Color fundus photograph · 45° FOV: 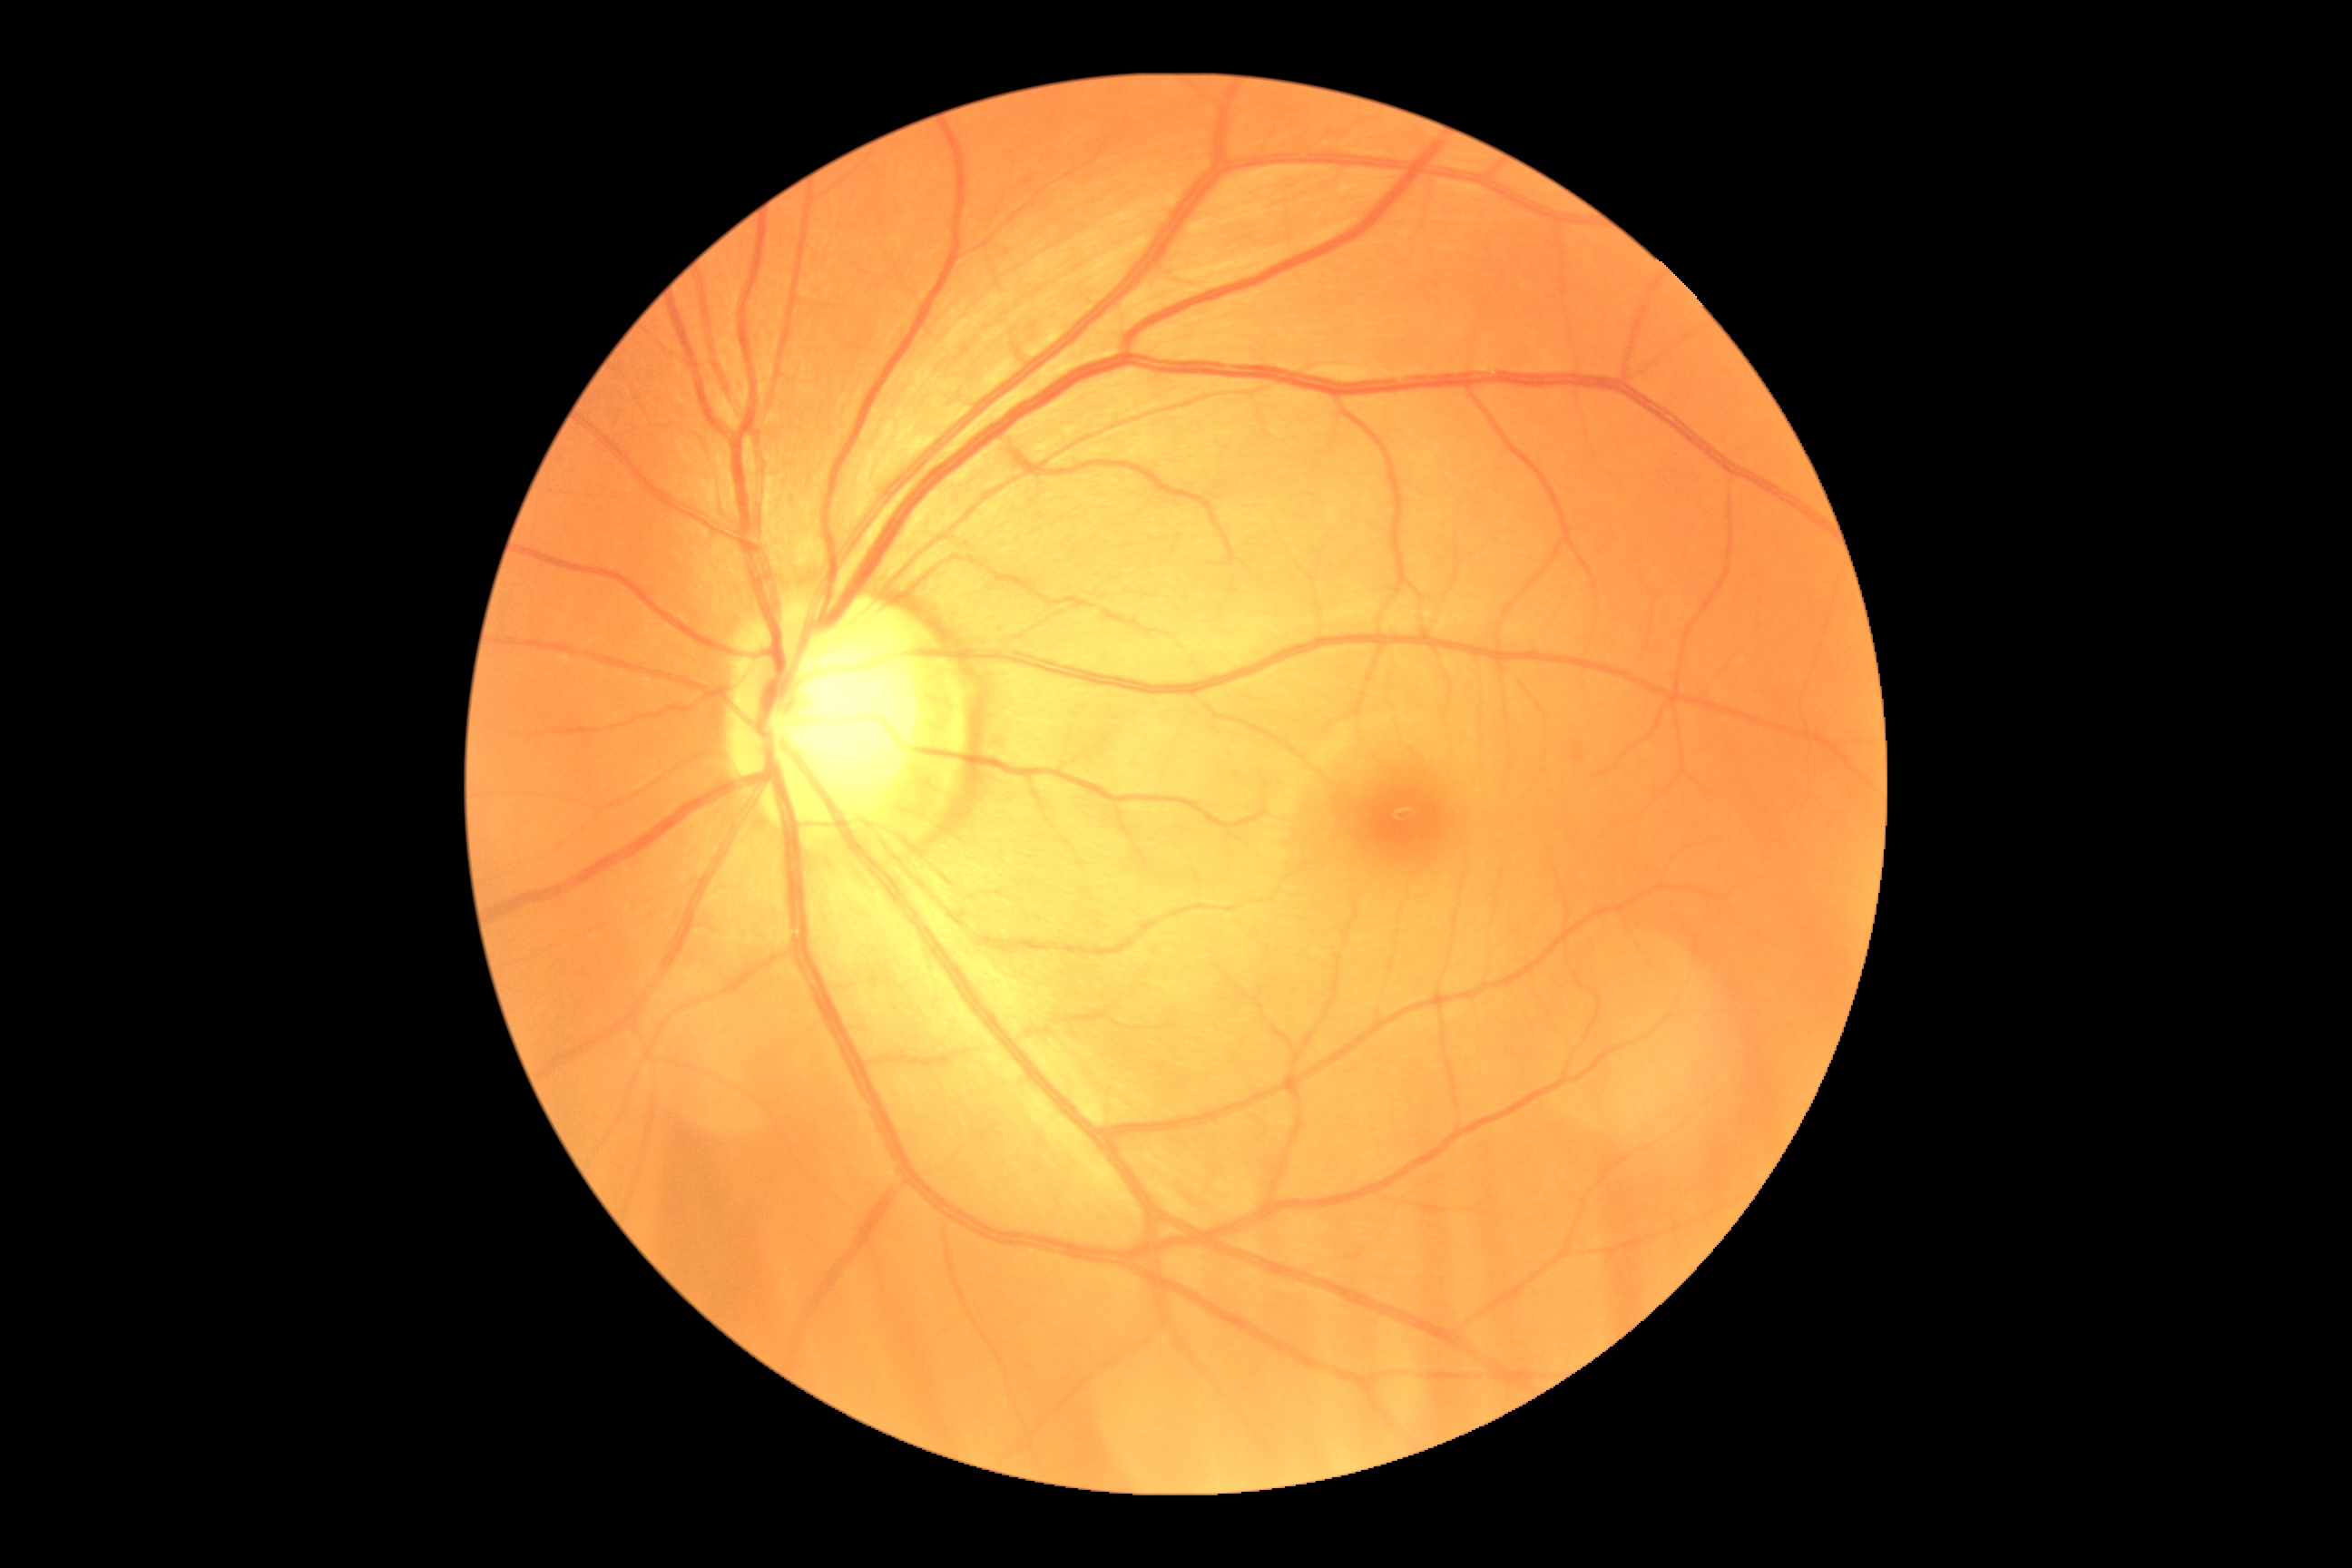
Annotations:
* DR impression — no apparent DR
* diabetic retinopathy grade — 0 (no apparent retinopathy)